Color fundus image. 2352 by 1568 pixels — 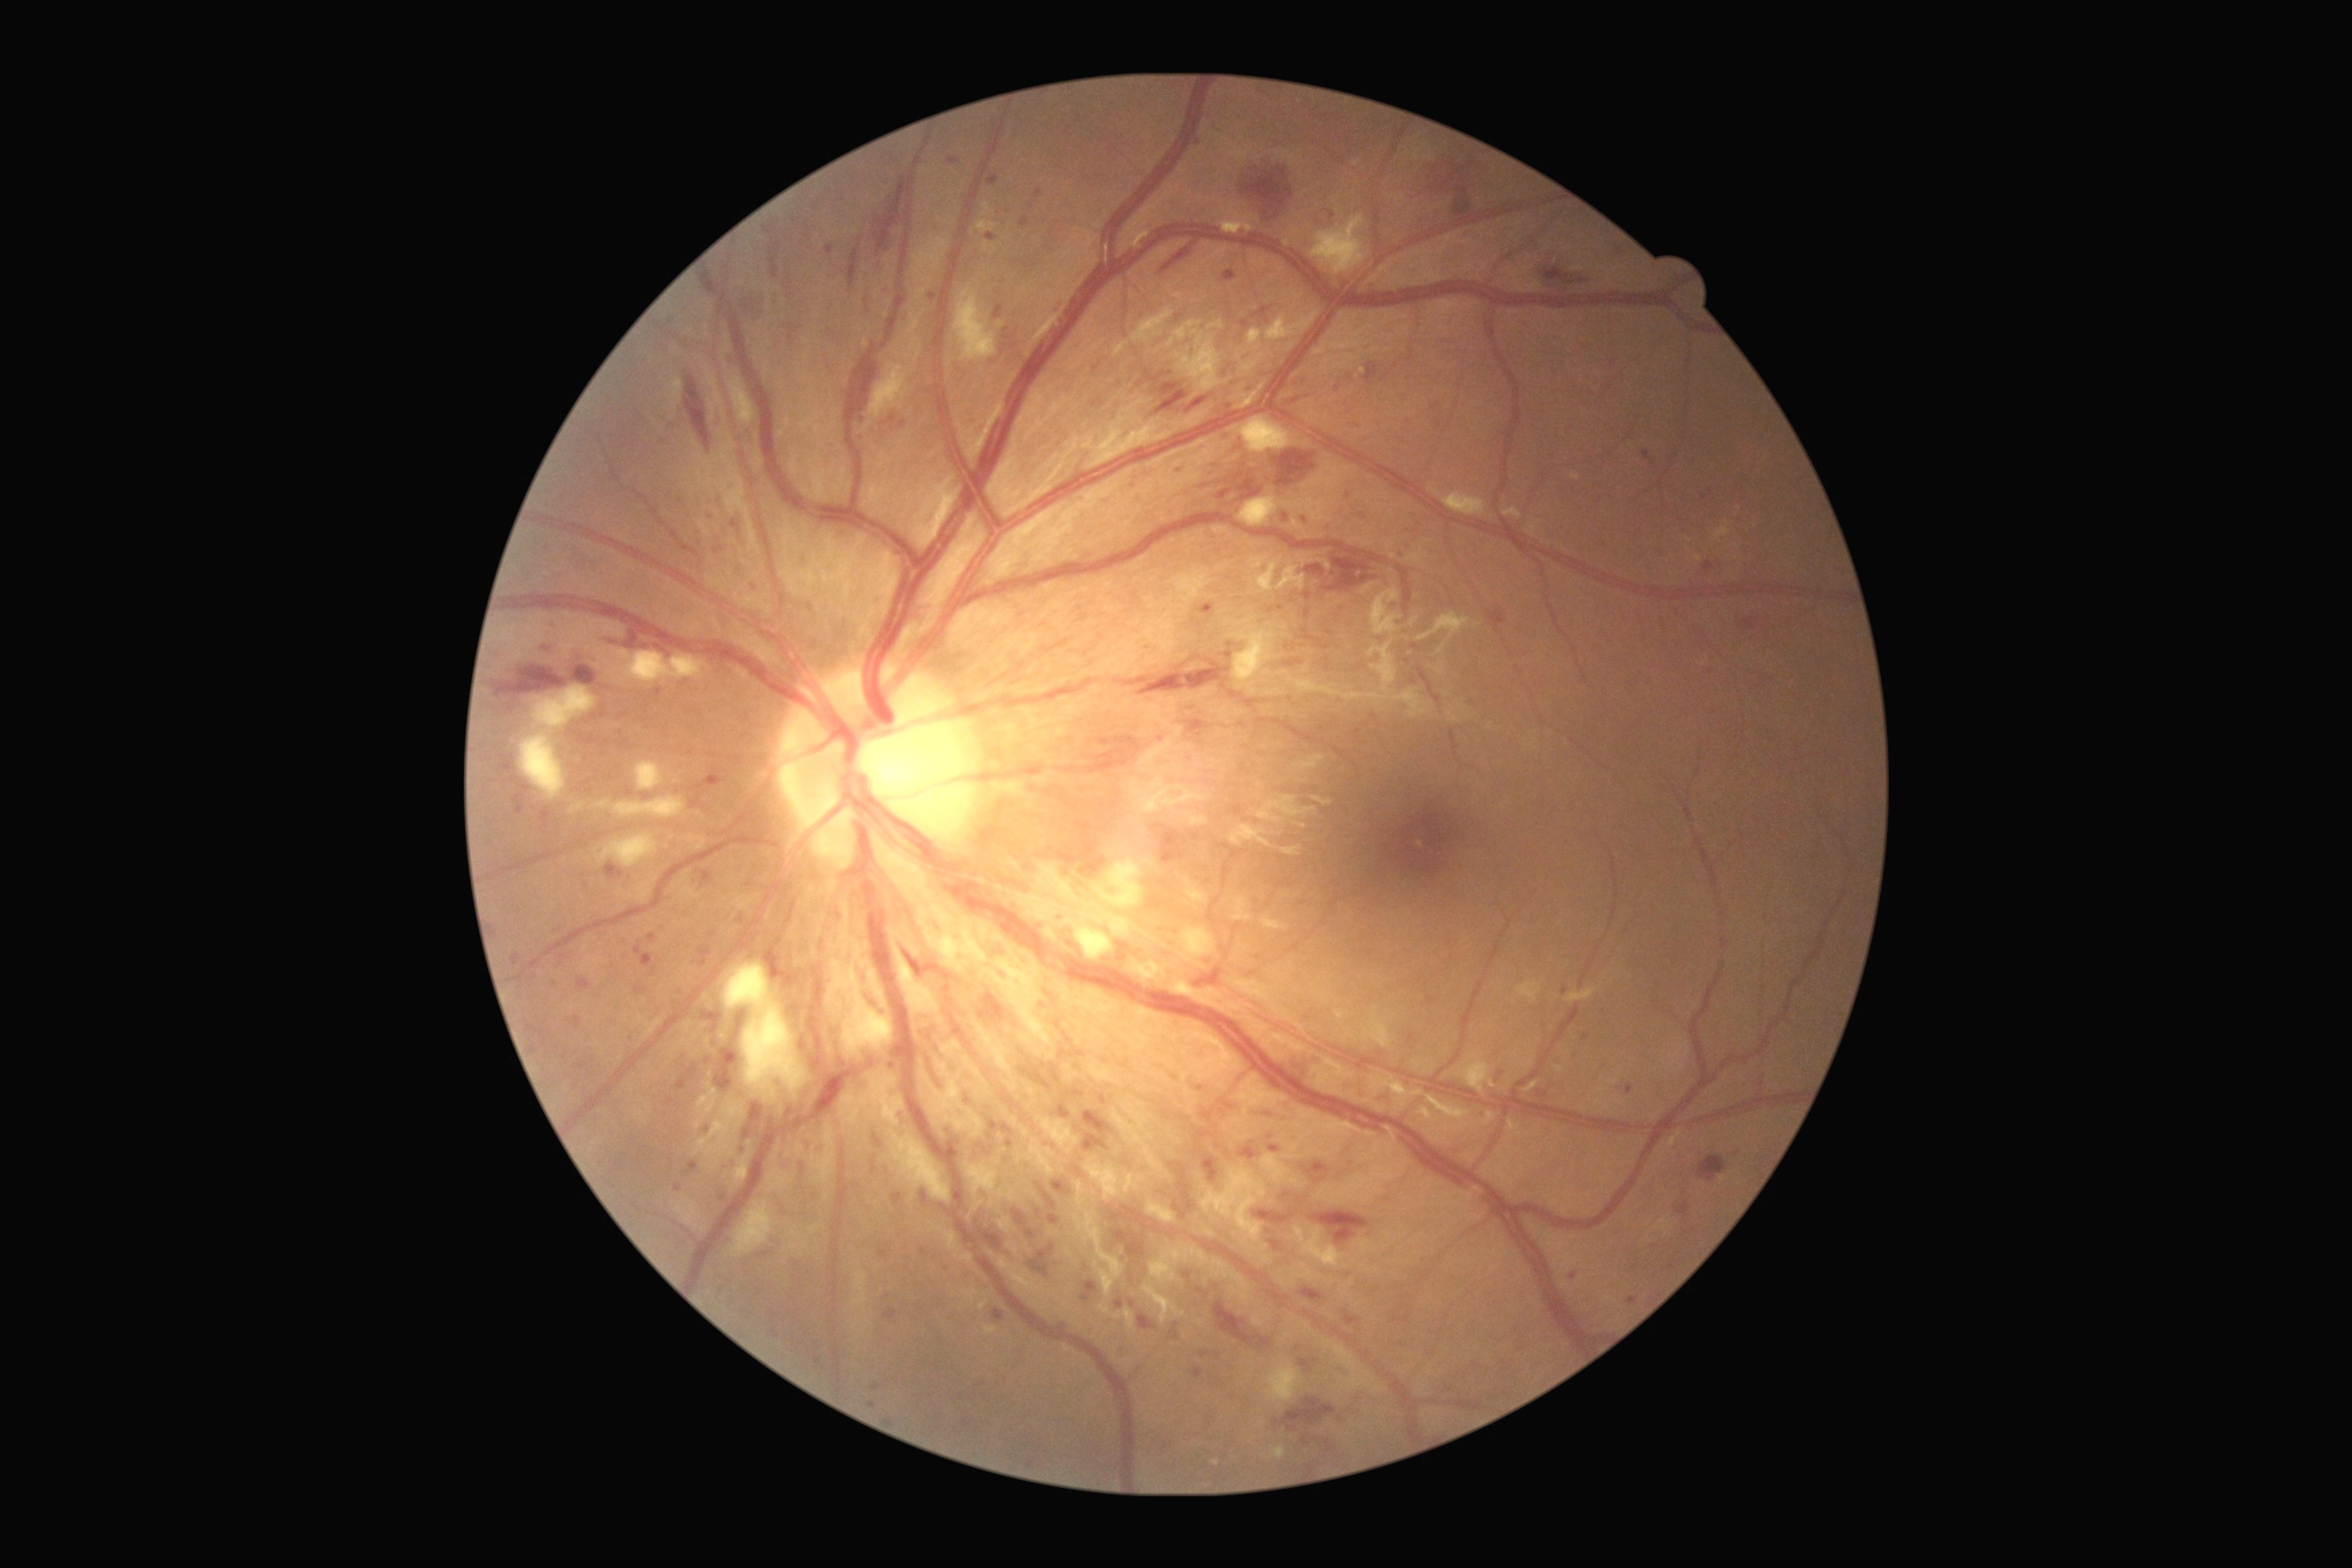 Diabetic retinopathy (DR) is grade 3 (severe NPDR)
Selected lesions:
microaneurysms (MAs) (partial): x1=885, y1=1309, x2=897, y2=1320; x1=948, y1=1141, x2=957, y2=1150; x1=1059, y1=1104, x2=1072, y2=1119; x1=605, y1=863, x2=625, y2=879; x1=712, y1=776, x2=720, y2=790; x1=720, y1=502, x2=723, y2=511; x1=1035, y1=190, x2=1043, y2=199; x1=763, y1=226, x2=774, y2=237; x1=1269, y1=1146, x2=1280, y2=1153; x1=513, y1=787, x2=529, y2=814; x1=1643, y1=451, x2=1649, y2=460
Small MAs near point(1280, 609); point(933, 297); point(1672, 1267); point(1103, 1100); point(1348, 496); point(808, 229); point(1101, 637); point(966, 1423)